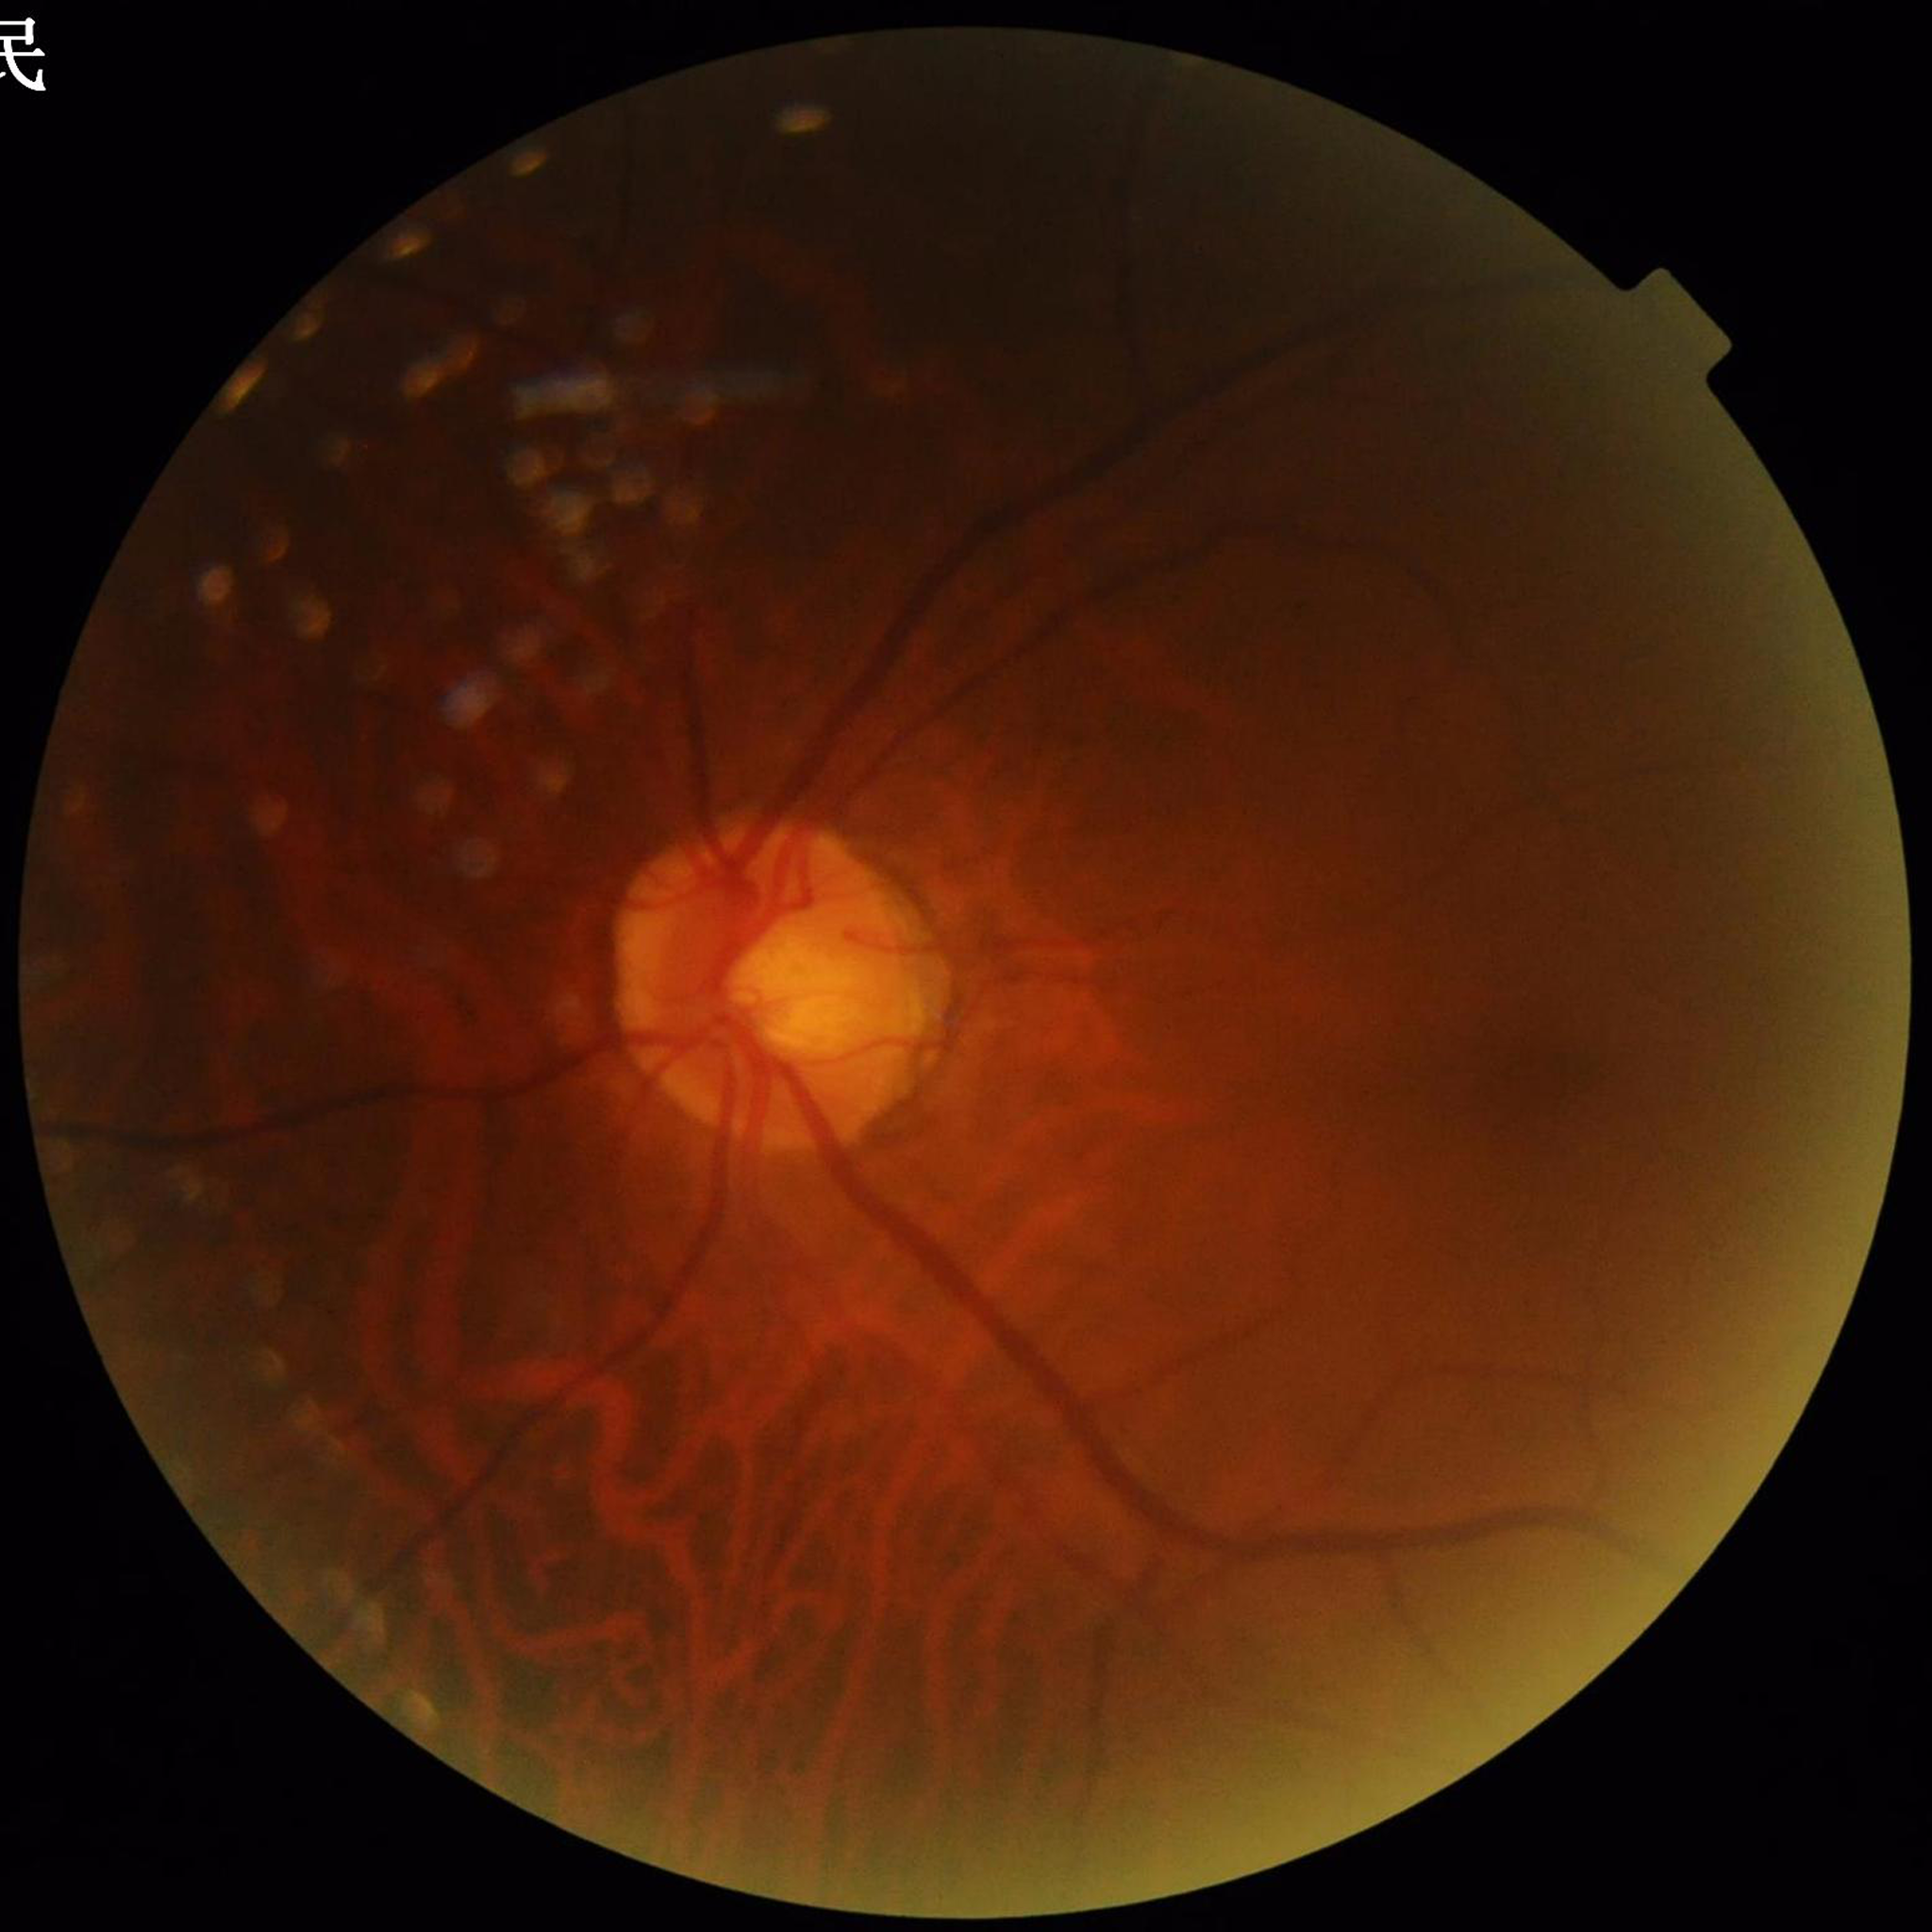 Disease: glaucoma | Automated quality assessment: illumination/color distortion present, blur present, contrast adequate.